848x848px. NIDEK AFC-230 fundus camera. Graded on the modified Davis scale. 45° FOV. Nonmydriatic — 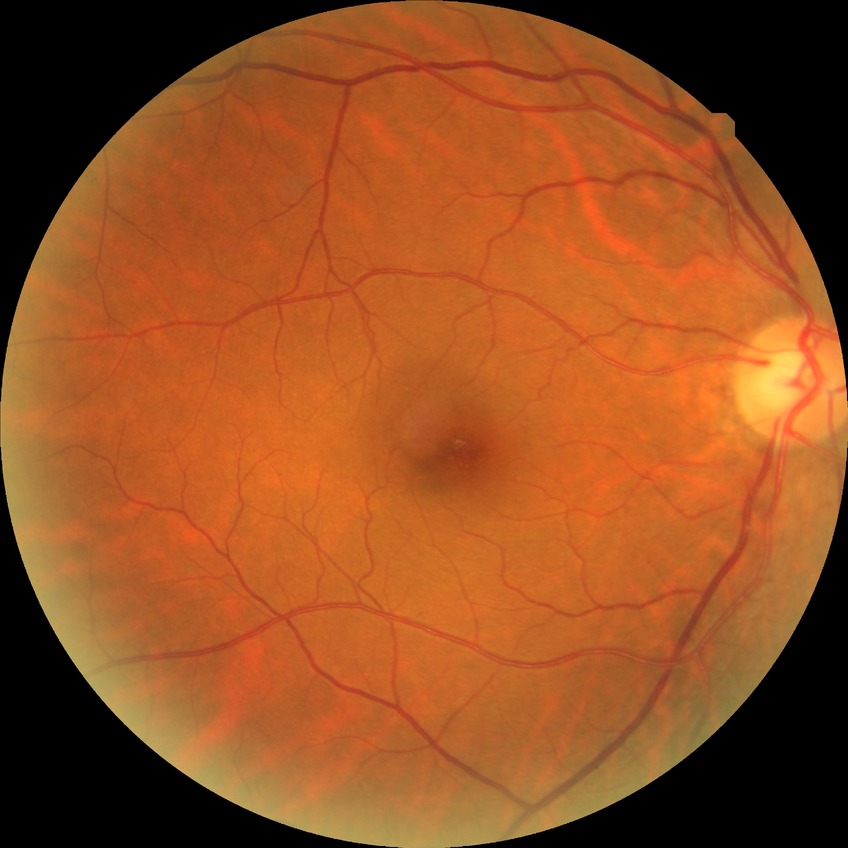

Modified Davis grading is no diabetic retinopathy.